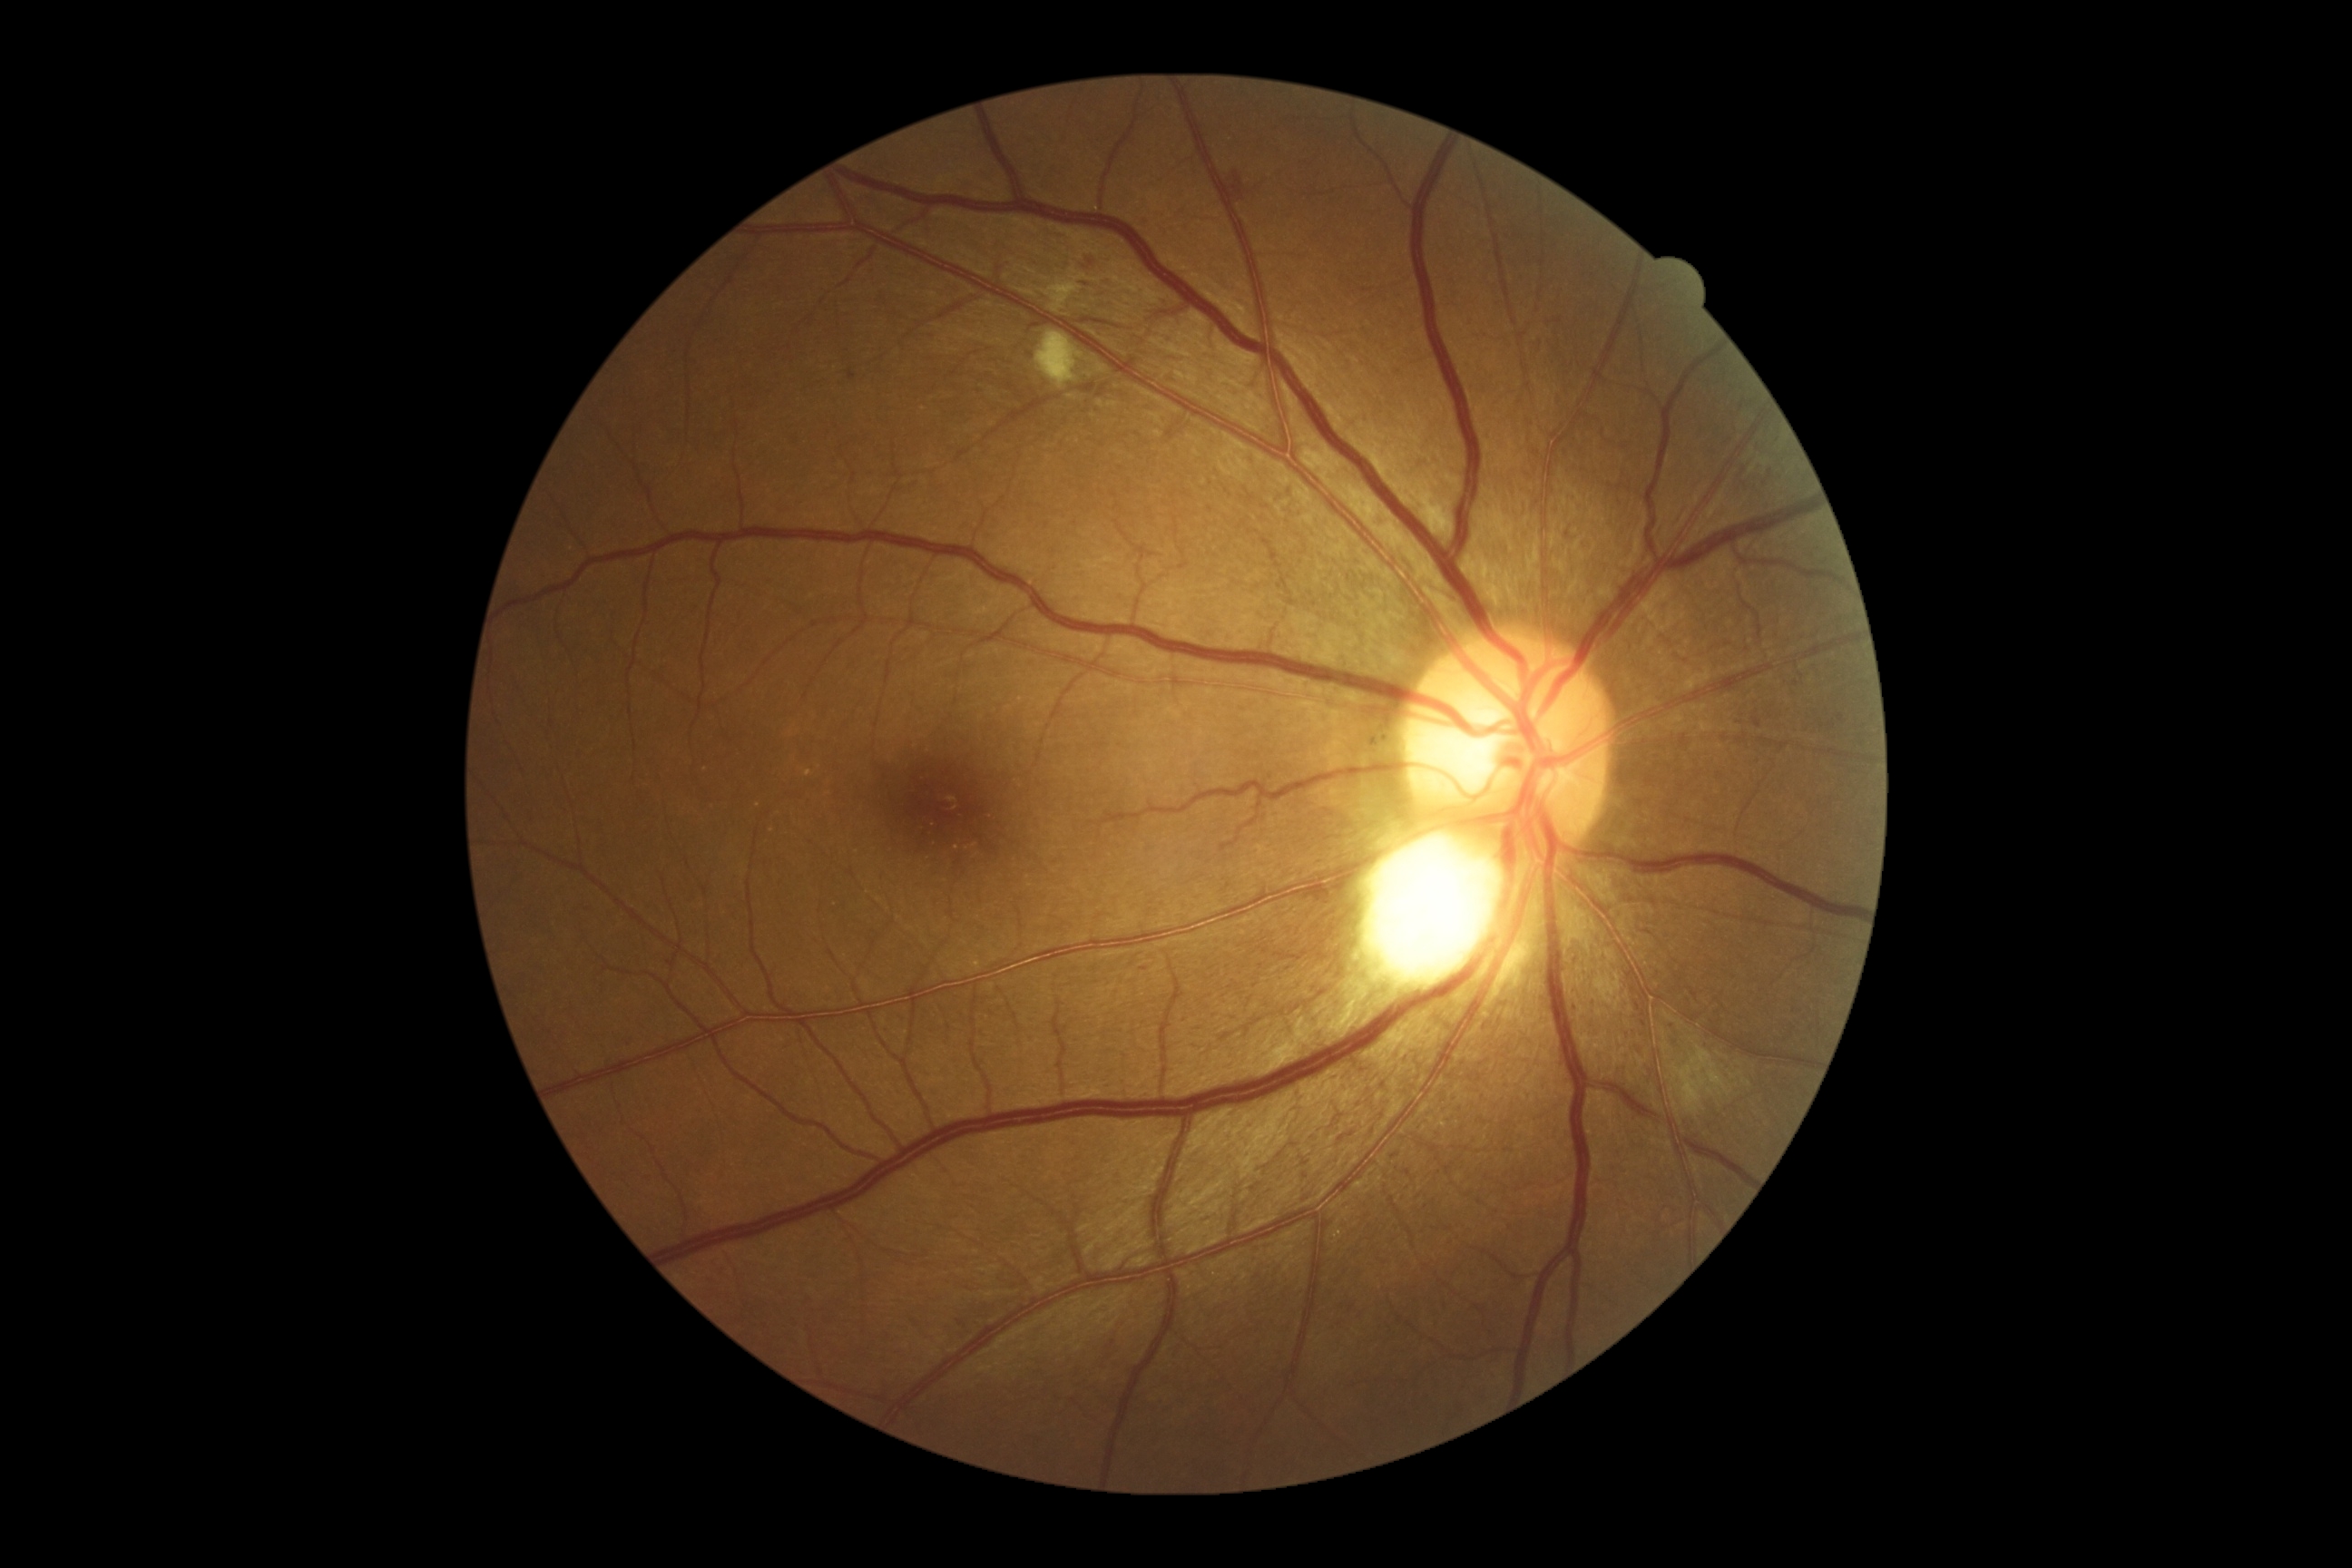 diabetic retinopathy (DR)@moderate NPDR (grade 2) — more than just microaneurysms but less than severe NPDR.